Image size 2212x1659
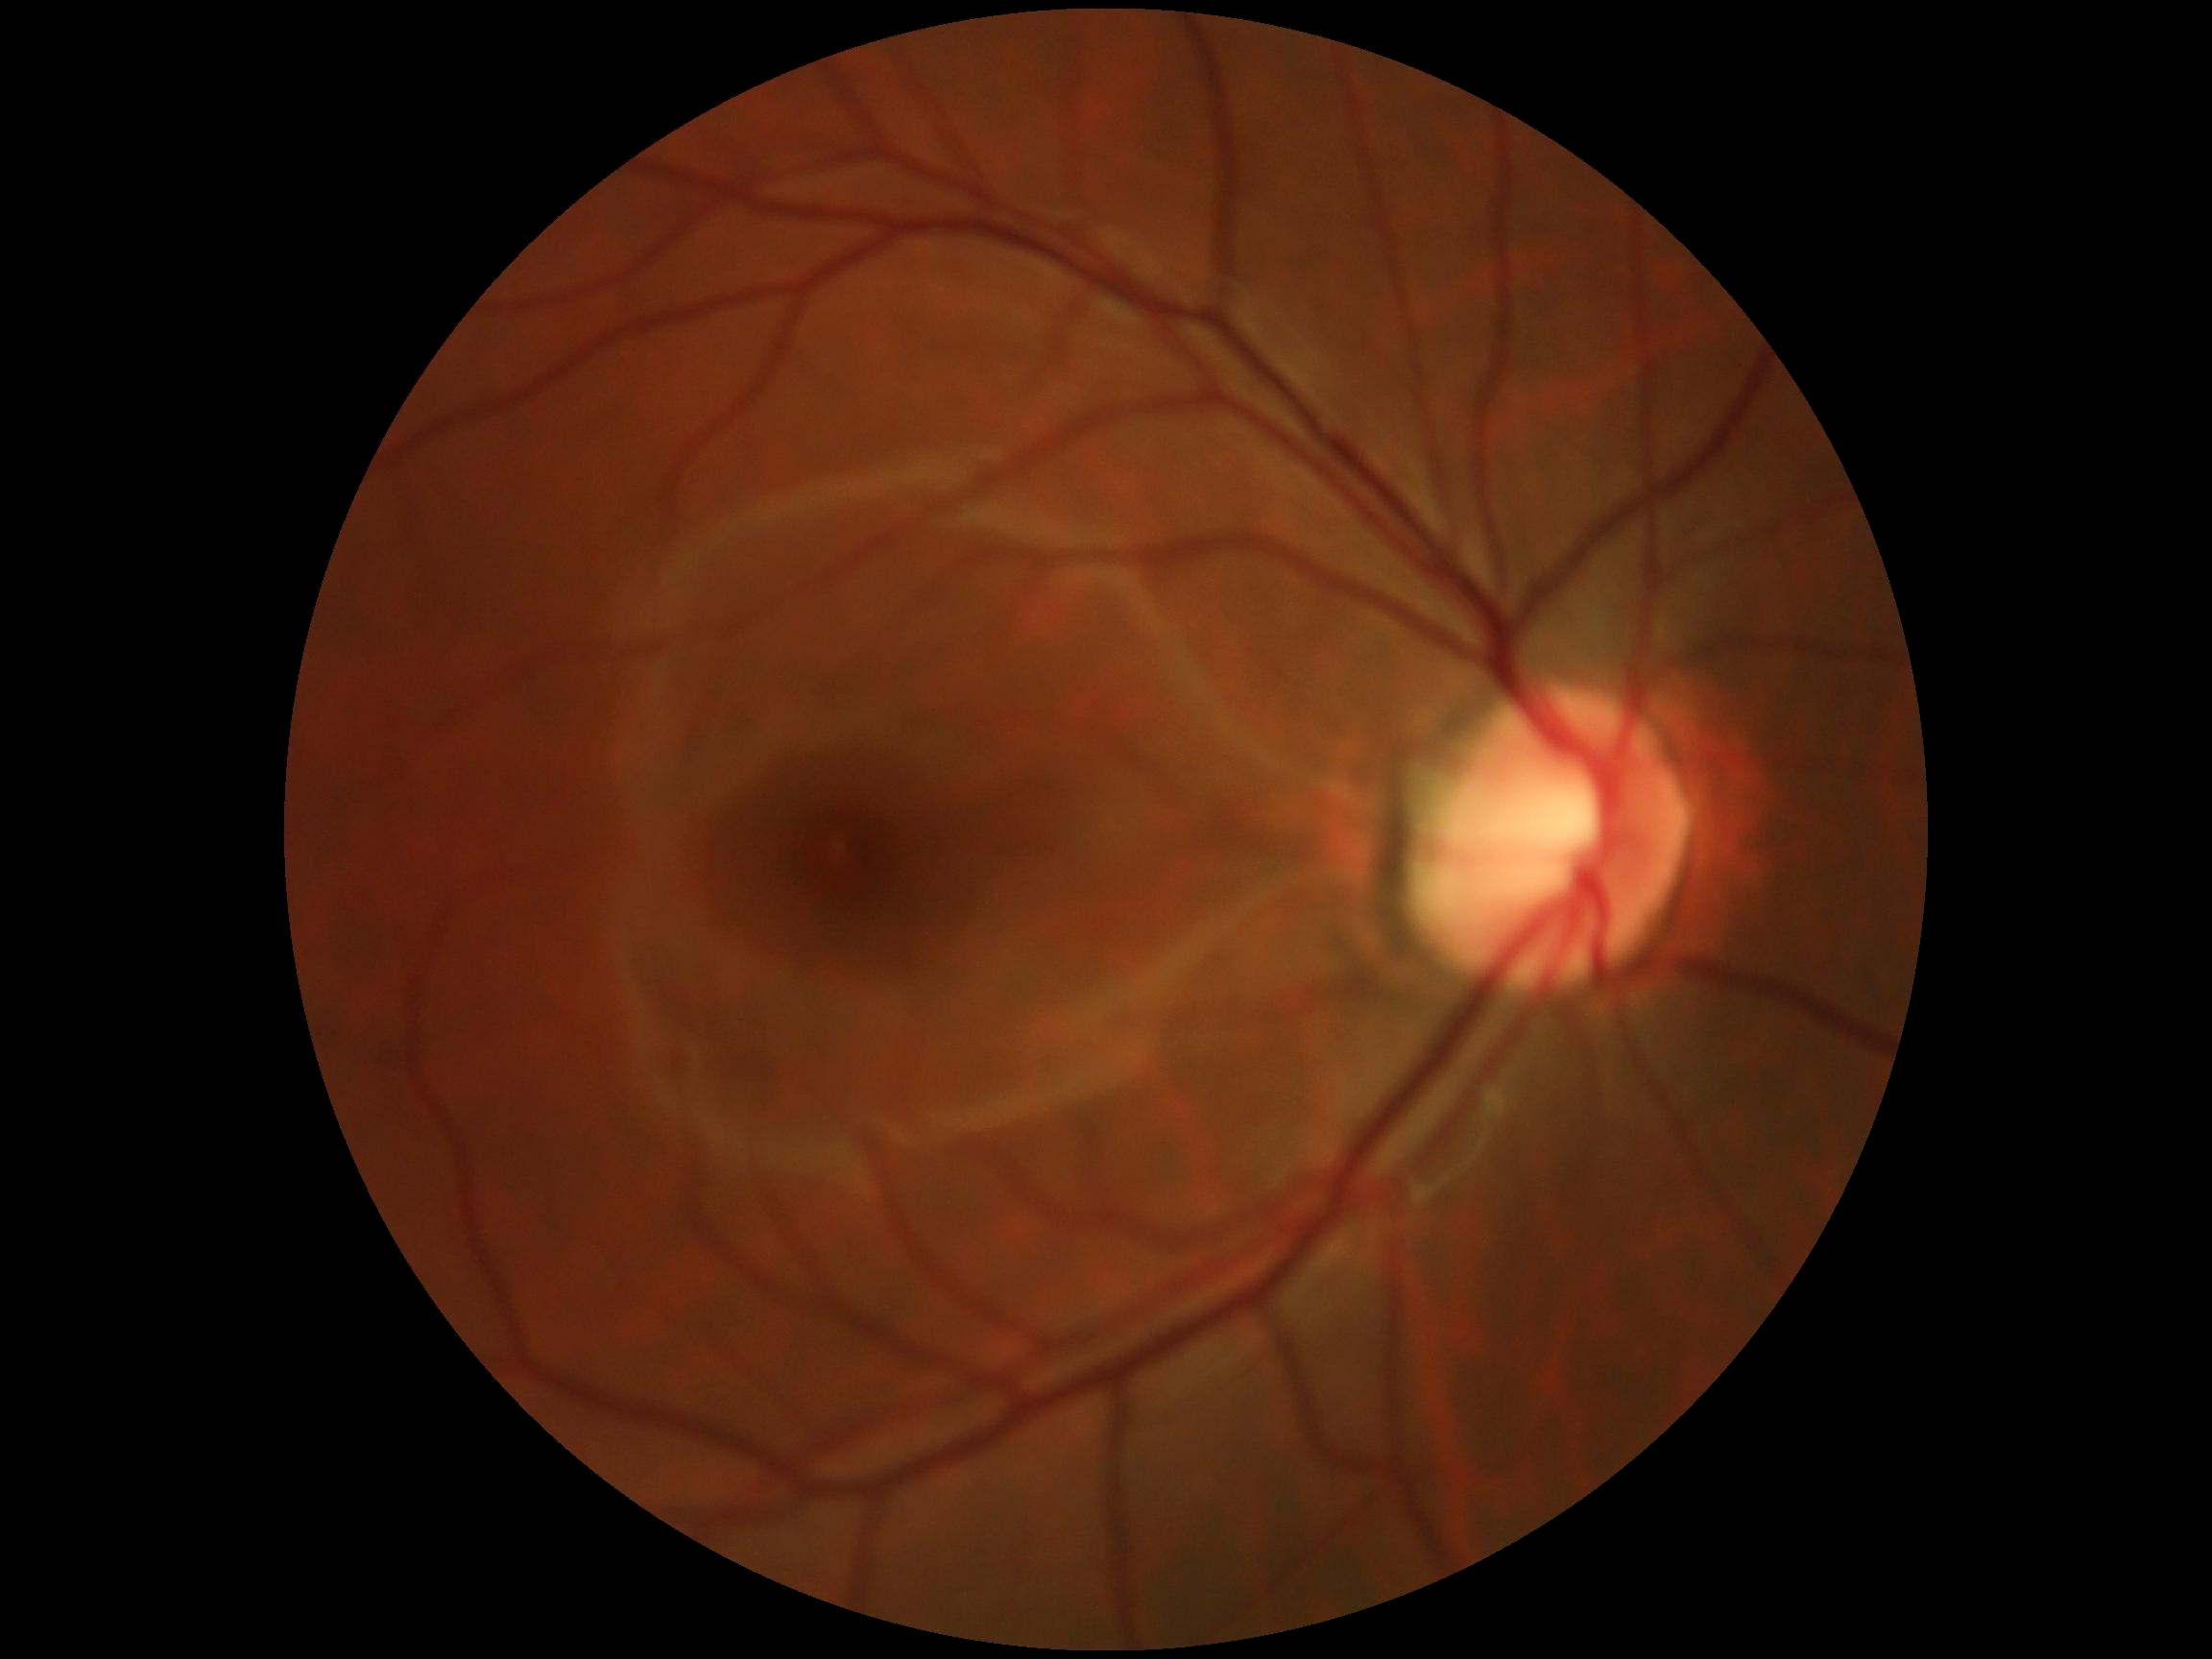
diabetic retinopathy (DR) = grade 0 (no apparent retinopathy)